1240 x 1240 pixels; Phoenix ICON wide-field infant fundus image:
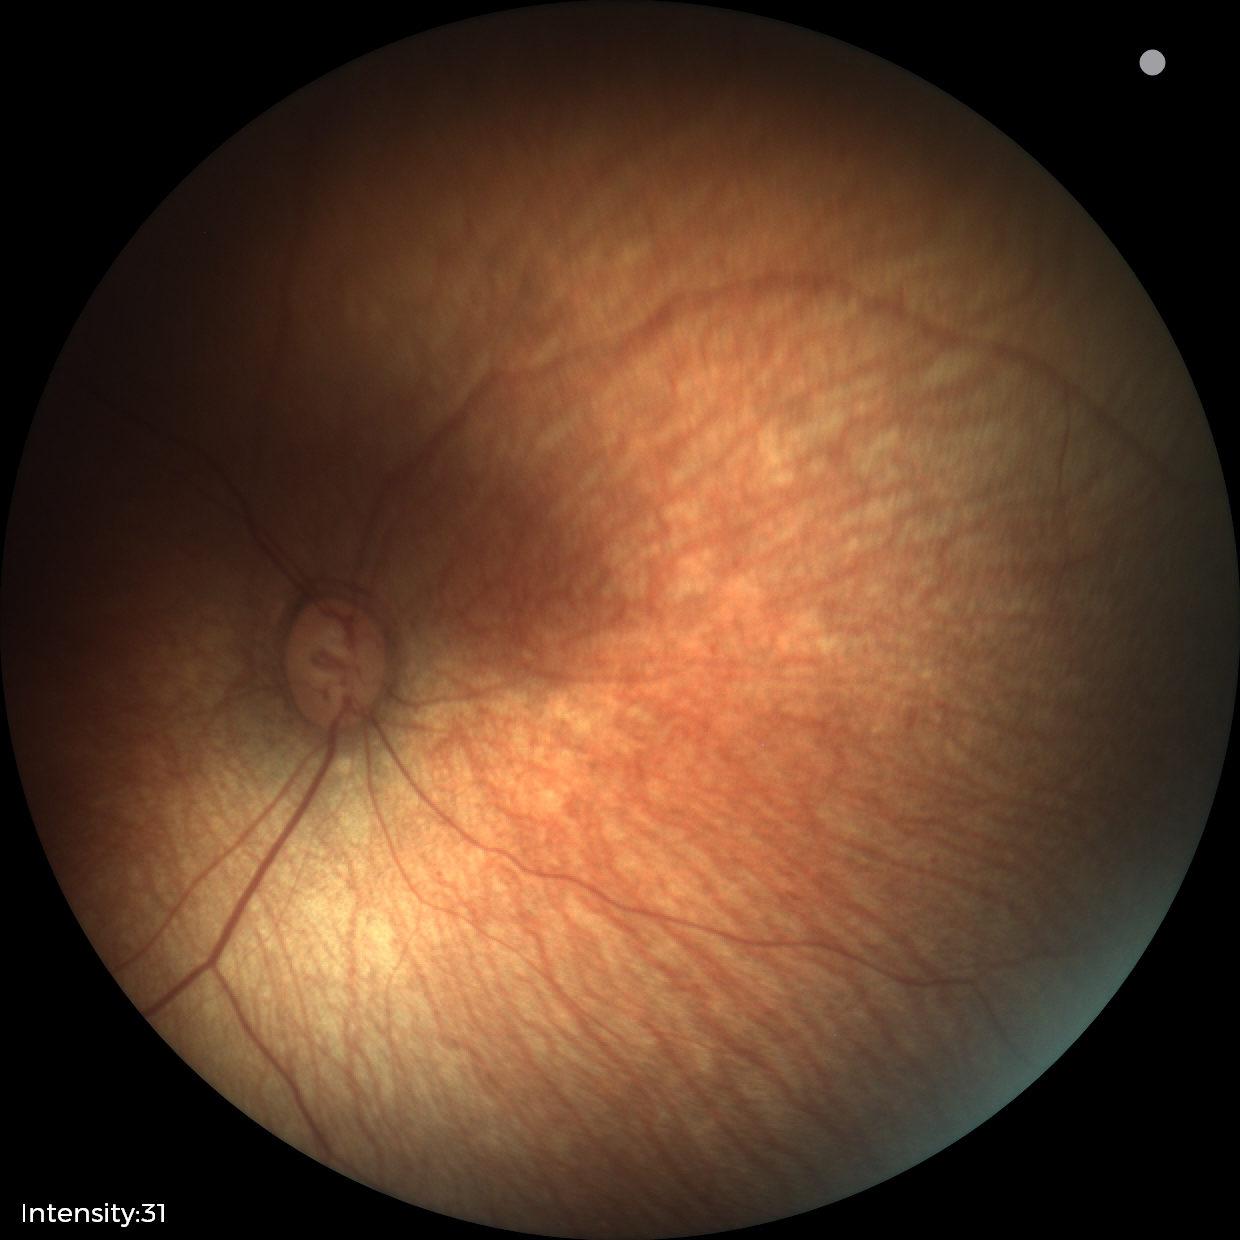

Impression: physiological finding.